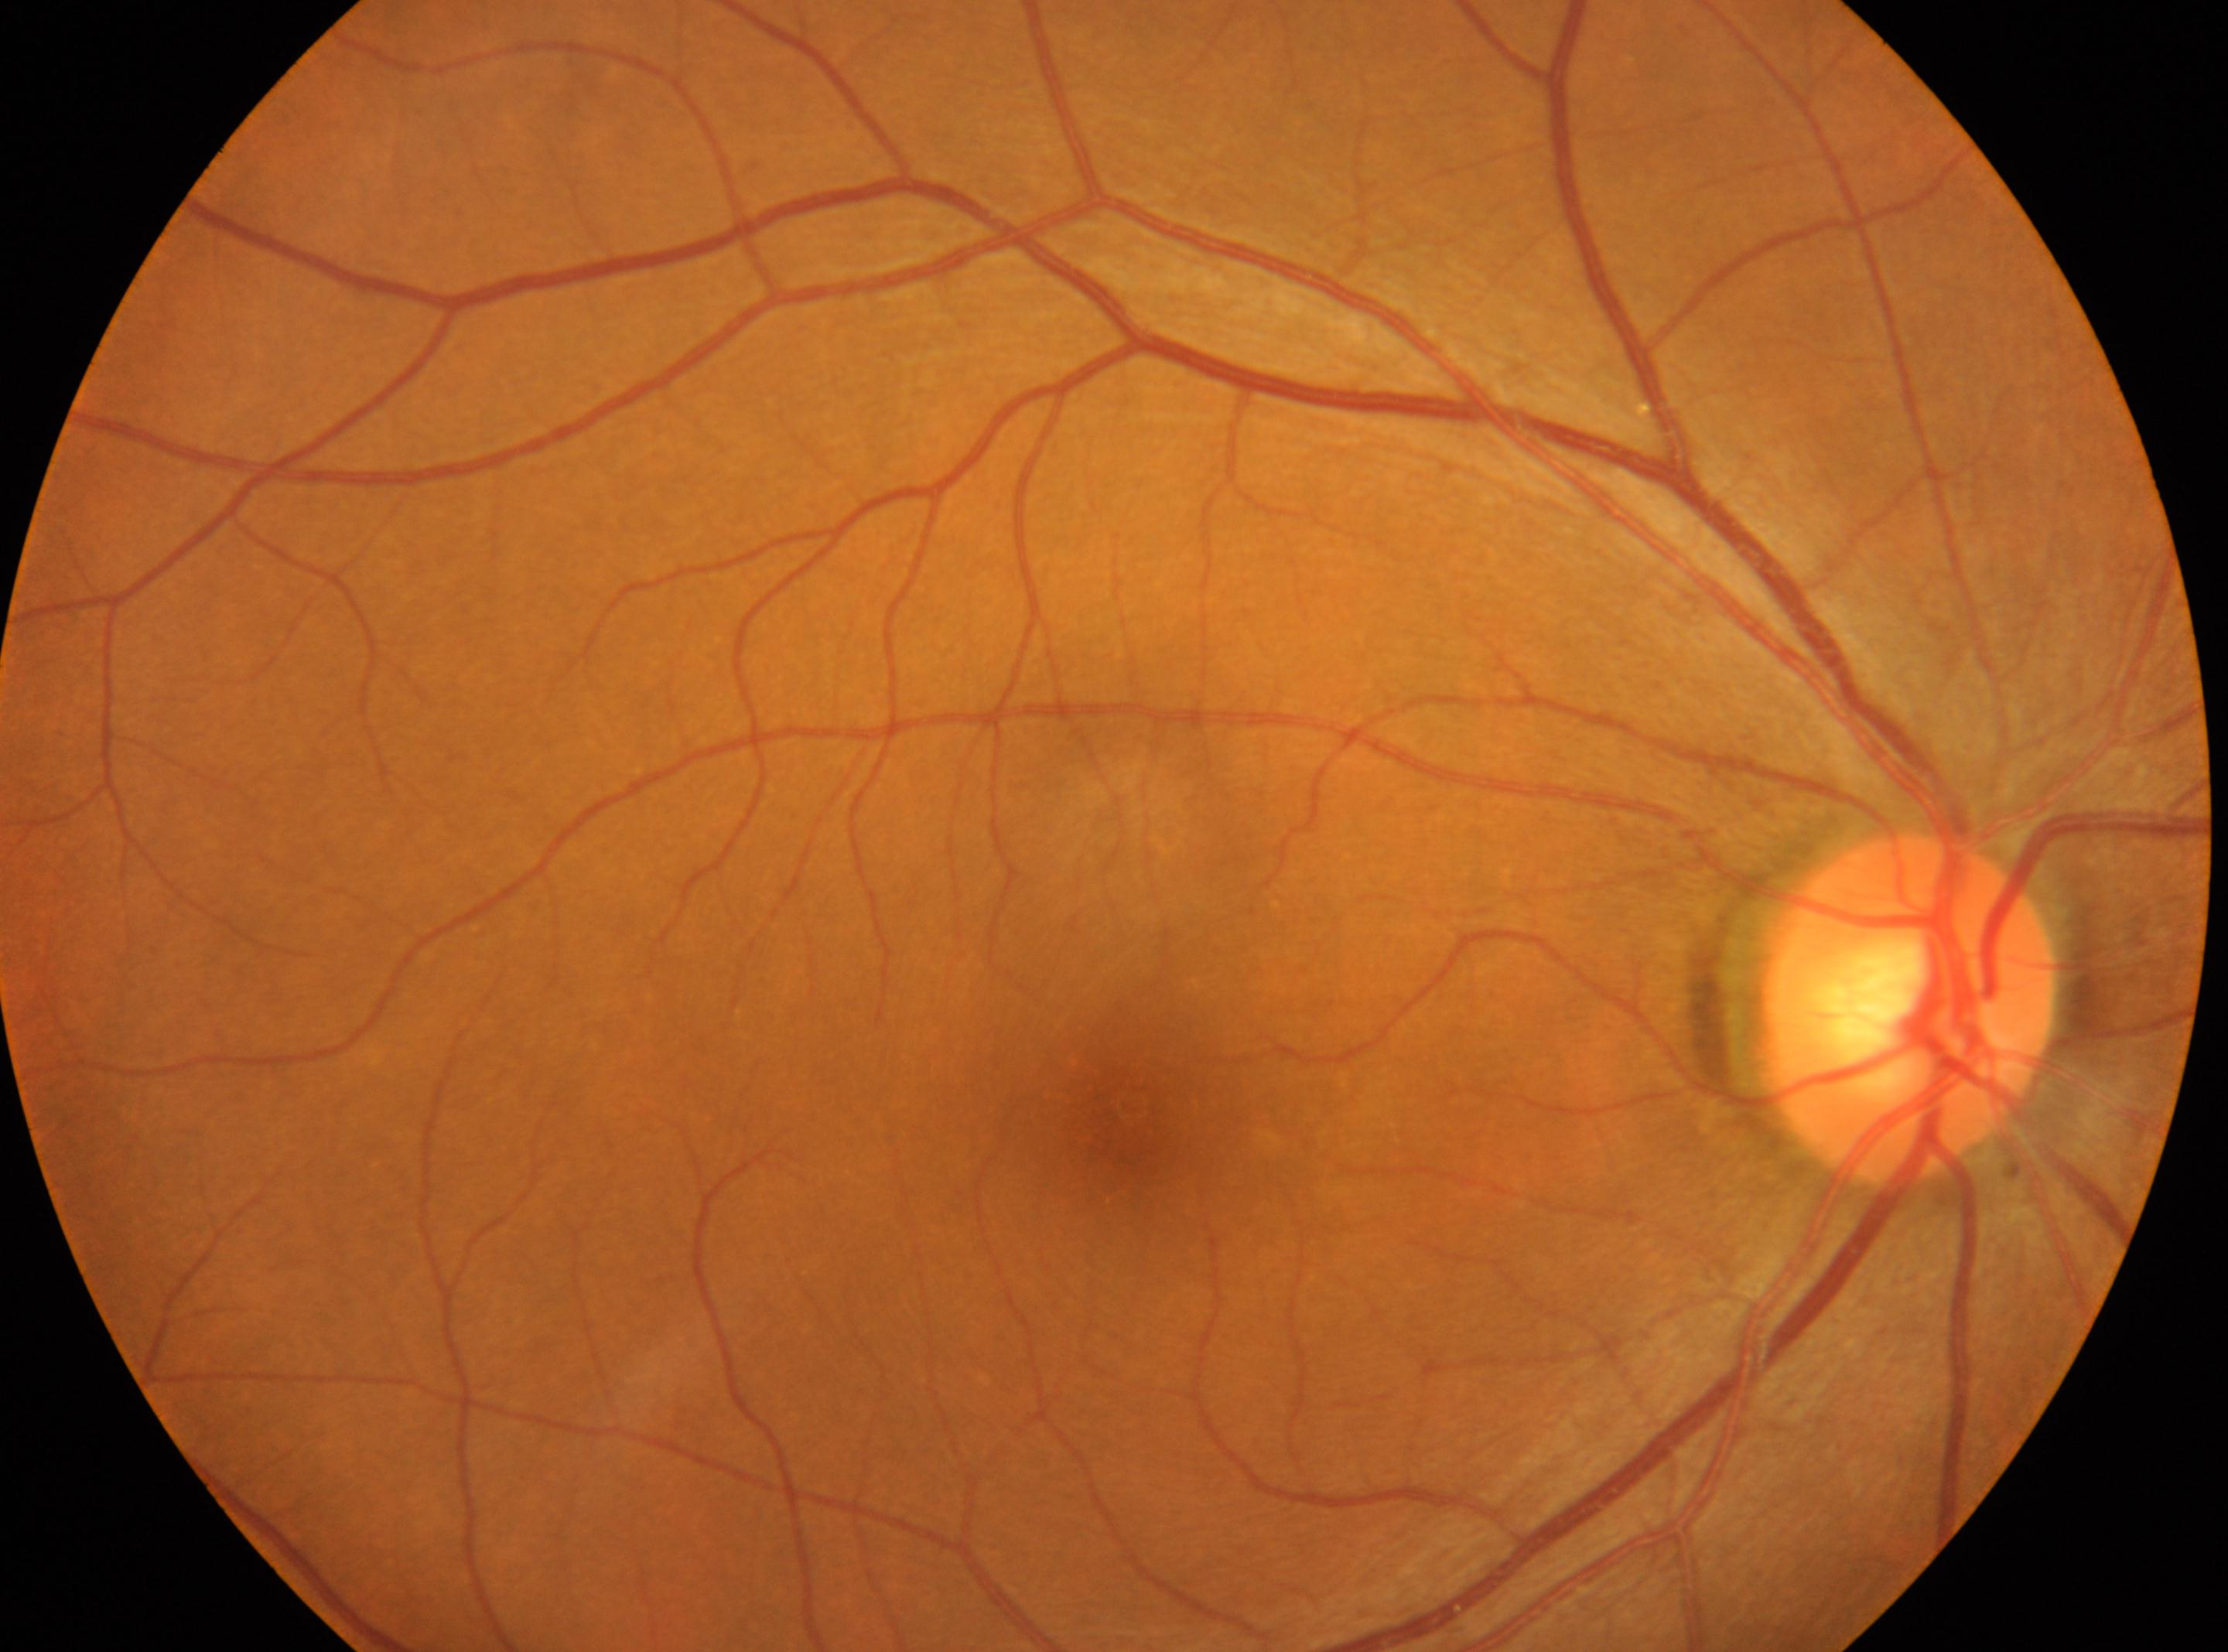 {"fovea": "(1133, 1104)", "dr_grade": "0 (no apparent retinopathy)", "eye": "right eye", "optic_disc": "(1908, 1010)"}